Fundus photo: 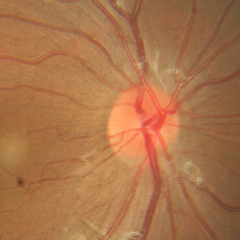 Glaucoma assessment = no evidence of glaucoma.